Nonmydriatic; NIDEK AFC-230; 848x848; 45° field of view.
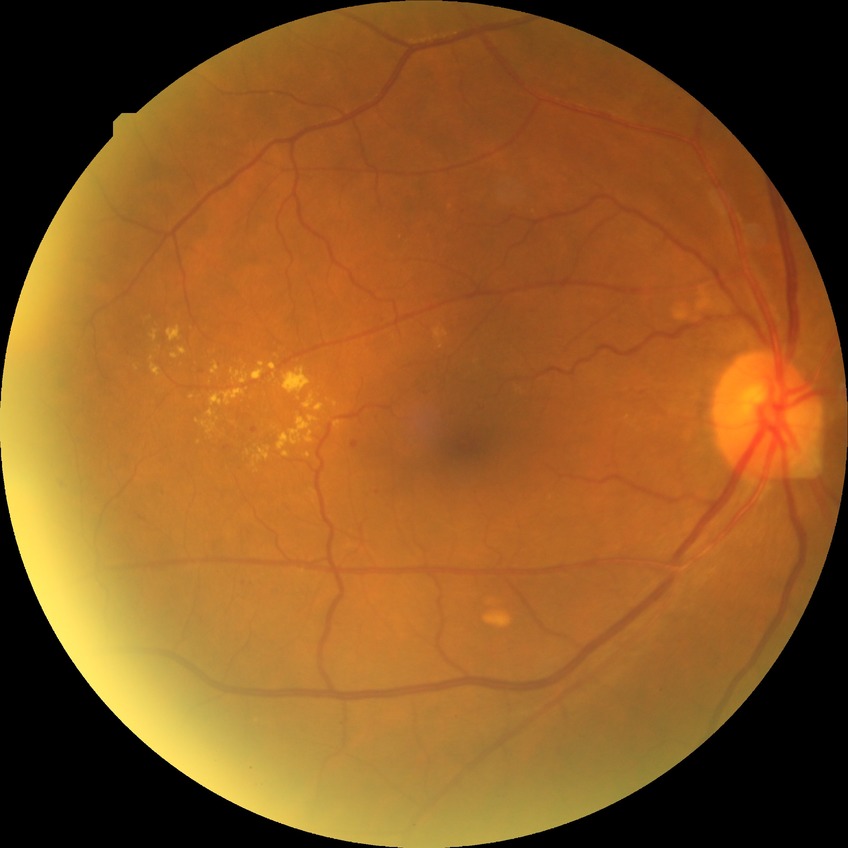

Retinopathy stage: simple diabetic retinopathy.